Davis DR grading
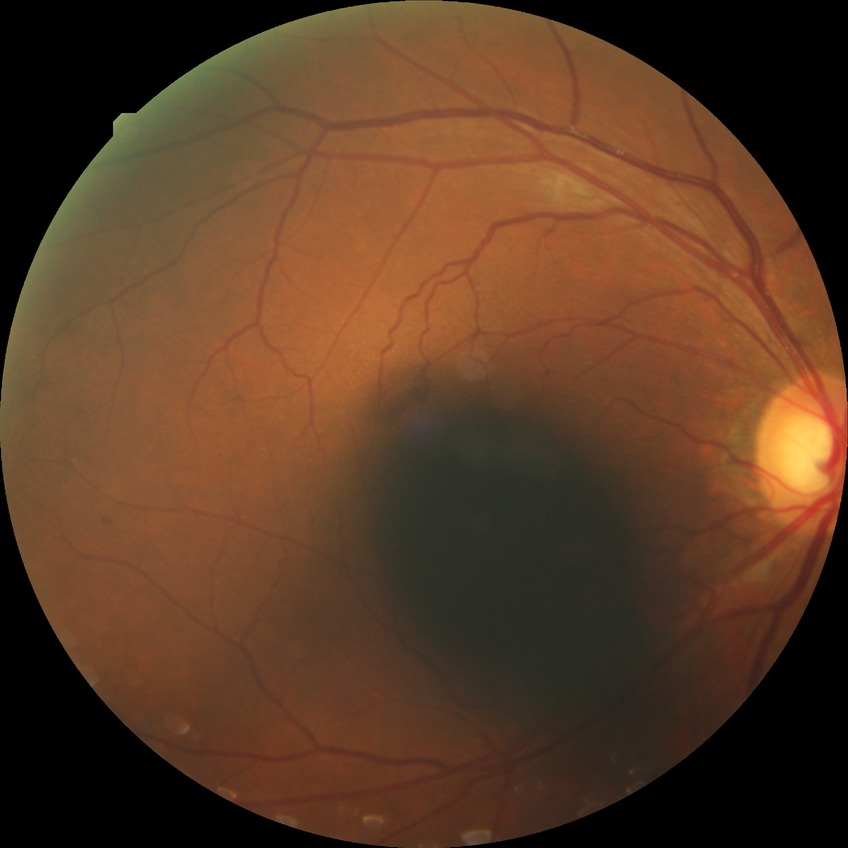
Diabetic retinopathy grade is no diabetic retinopathy.